45° FOV — 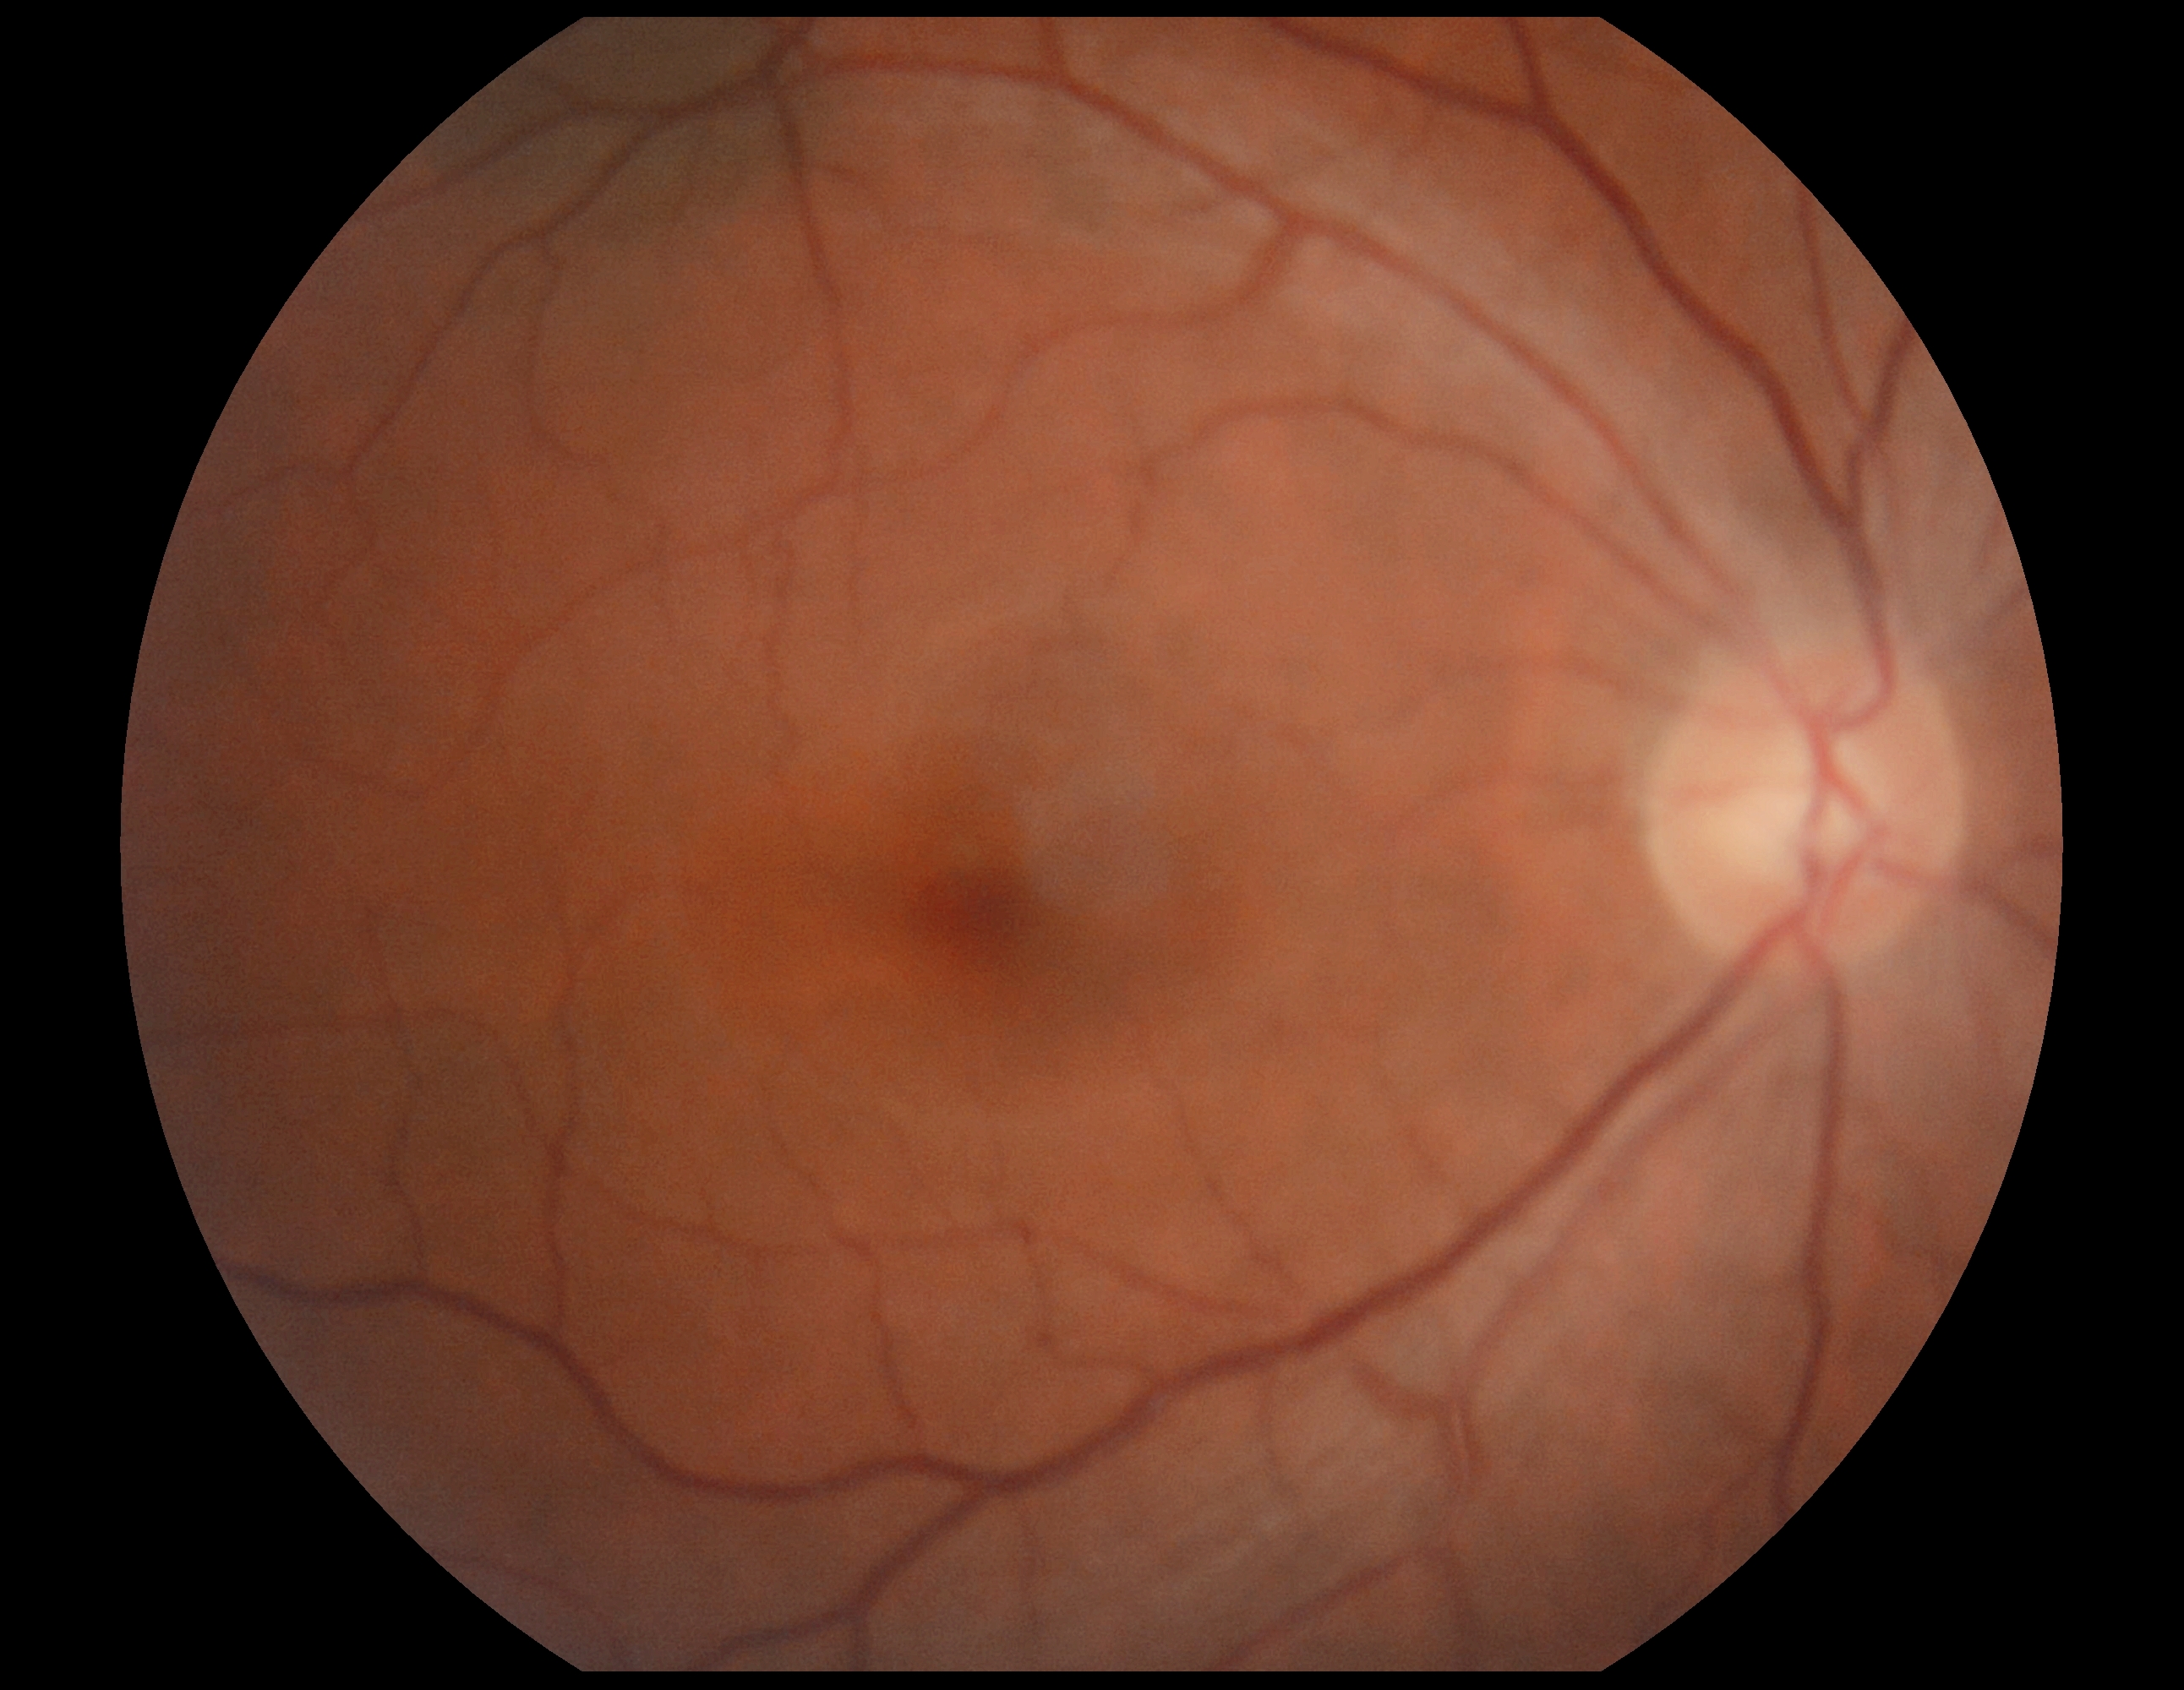

{"dr_grade": "0 (no apparent retinopathy)"}